Wide-field fundus photograph of an infant. Acquired on the Natus RetCam Envision. 1440 by 1080 pixels:
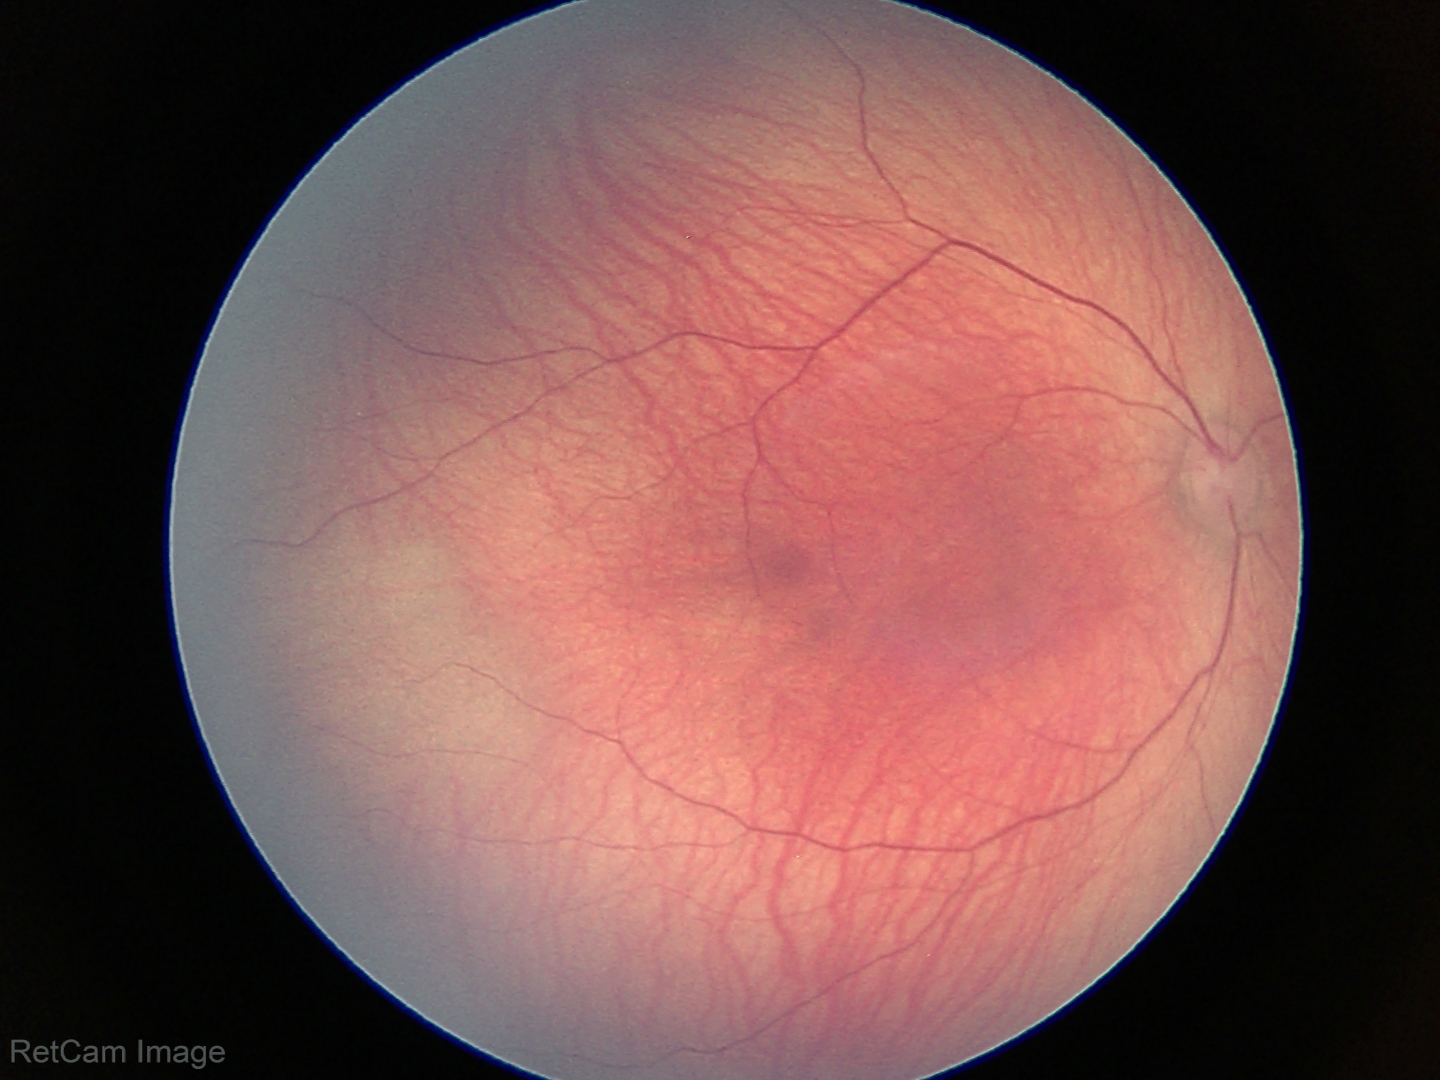
Screening examination with no abnormal retinal findings.